Fundus photo · 45-degree field of view: 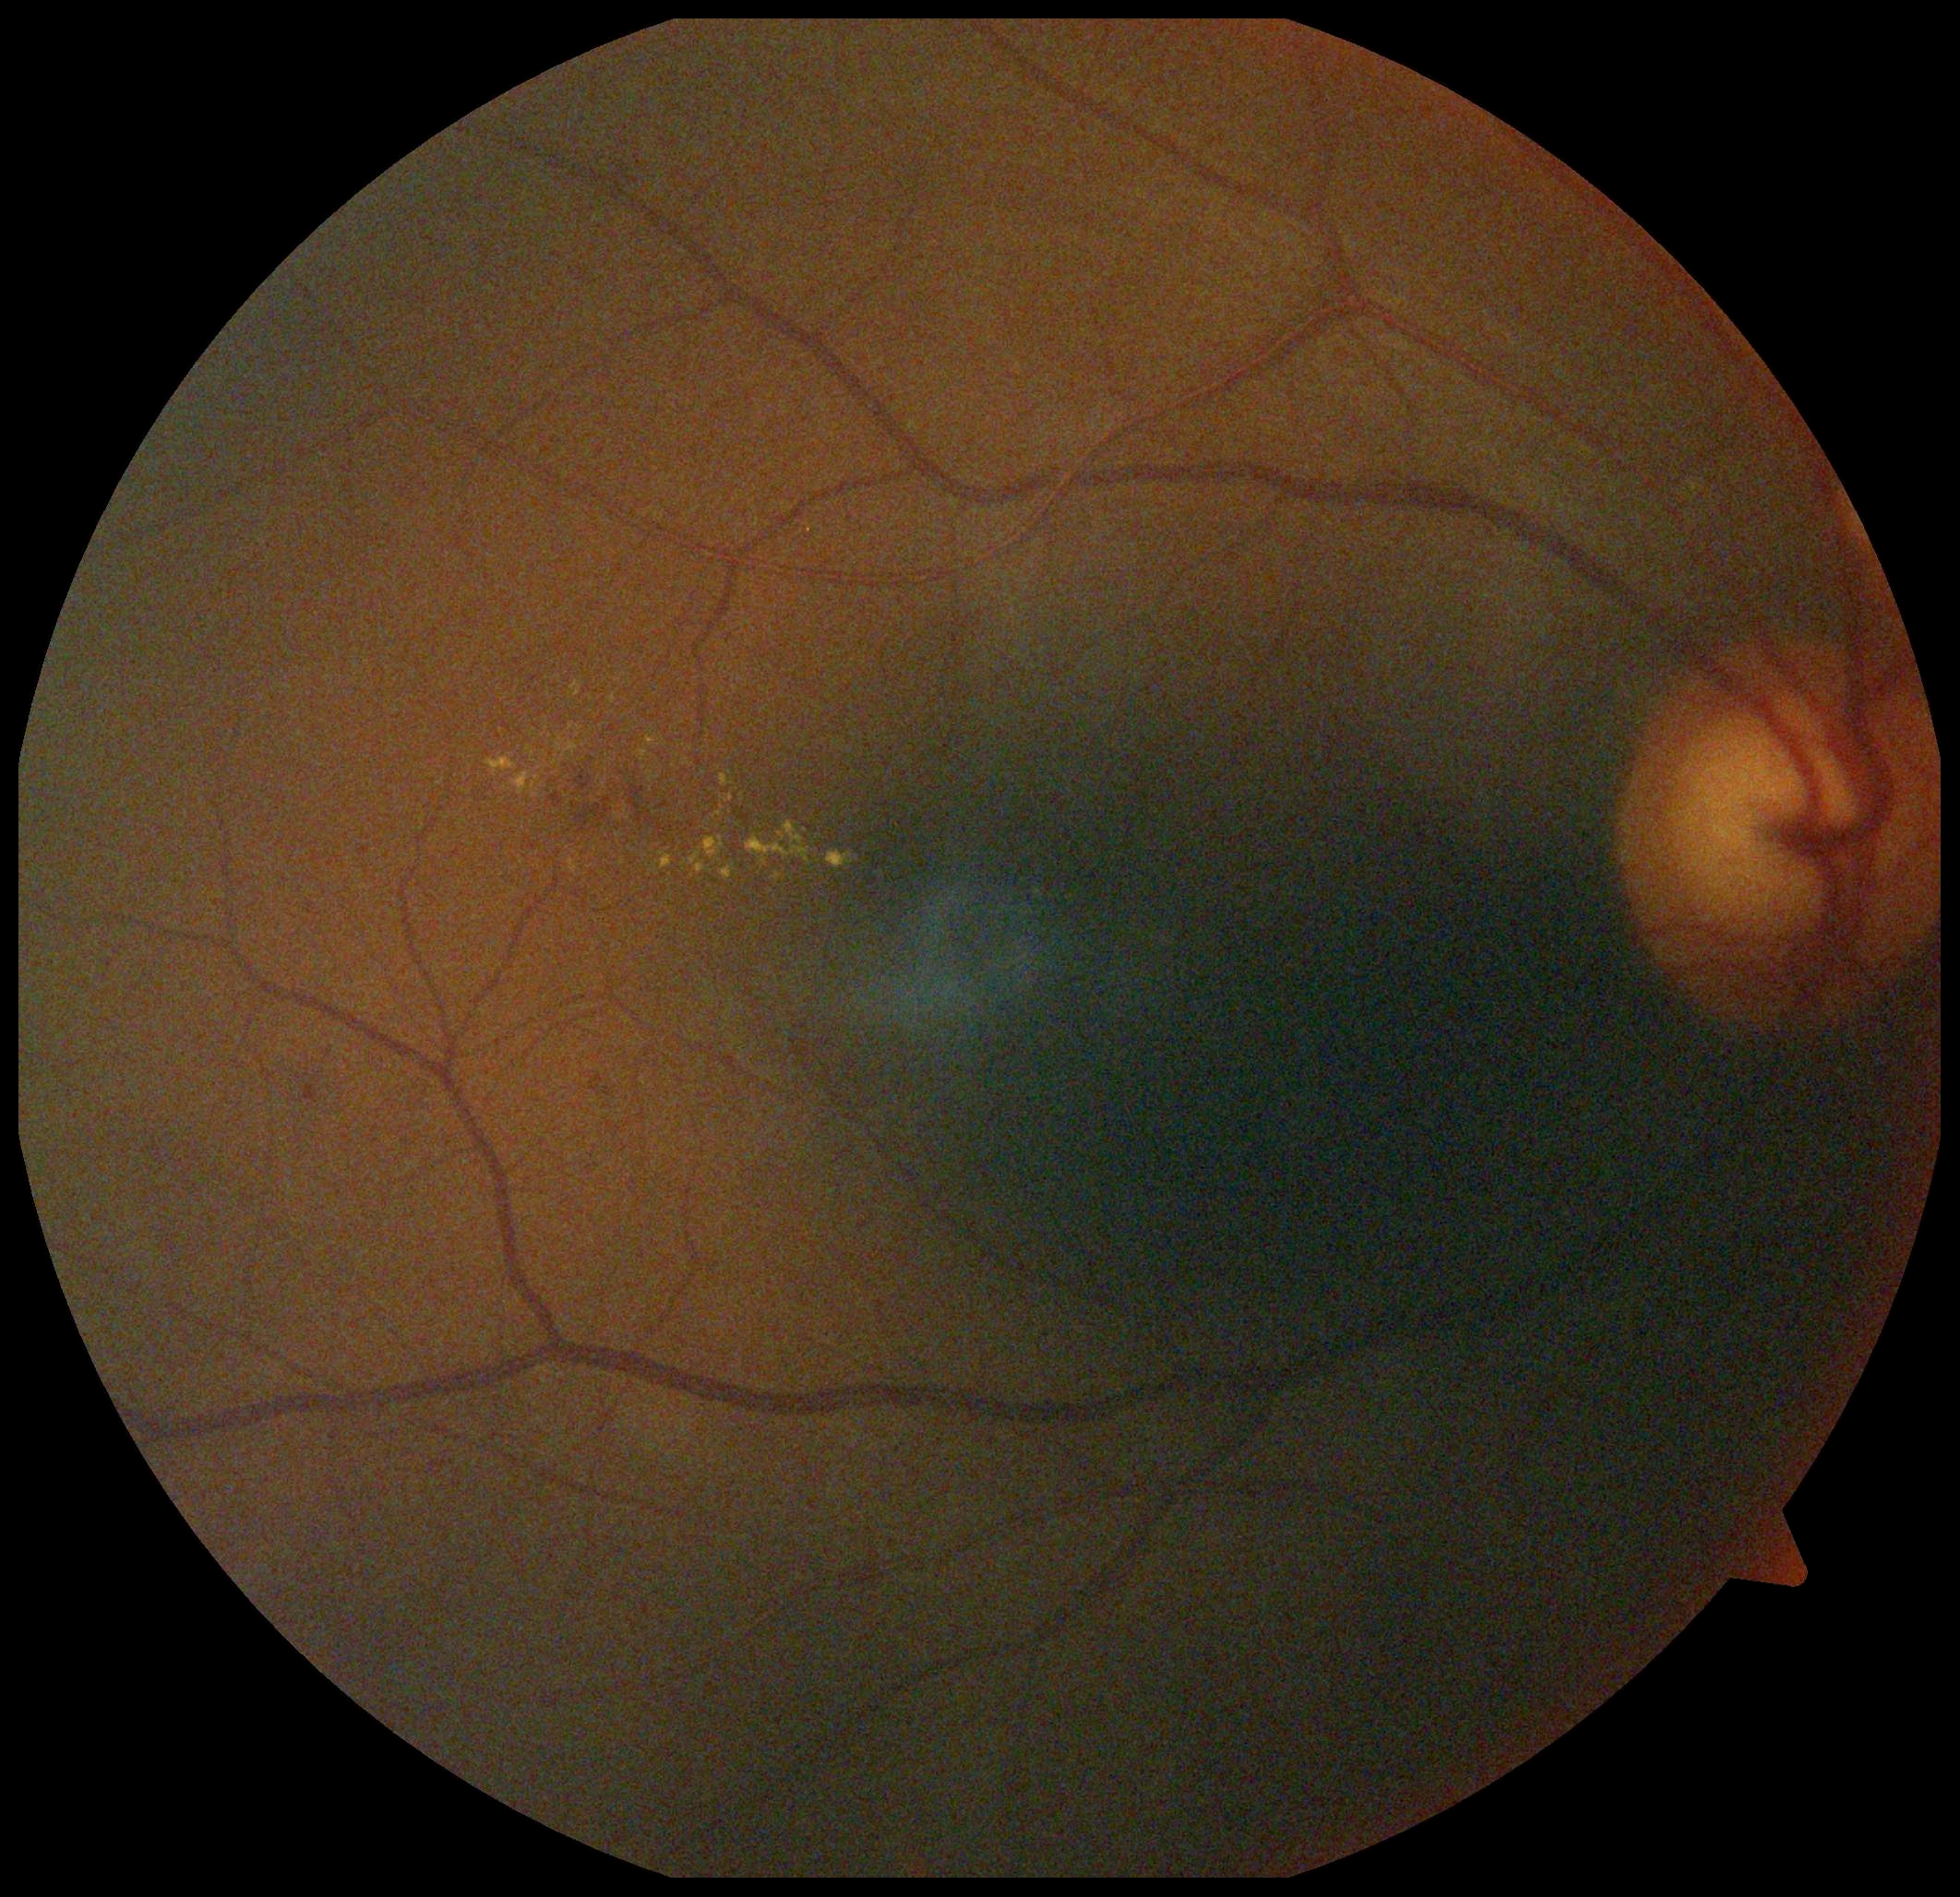 retinopathy grade@2 (moderate NPDR).